1240x1240. Captured with the Phoenix ICON (100° field of view). Wide-field fundus photograph from neonatal ROP screening:
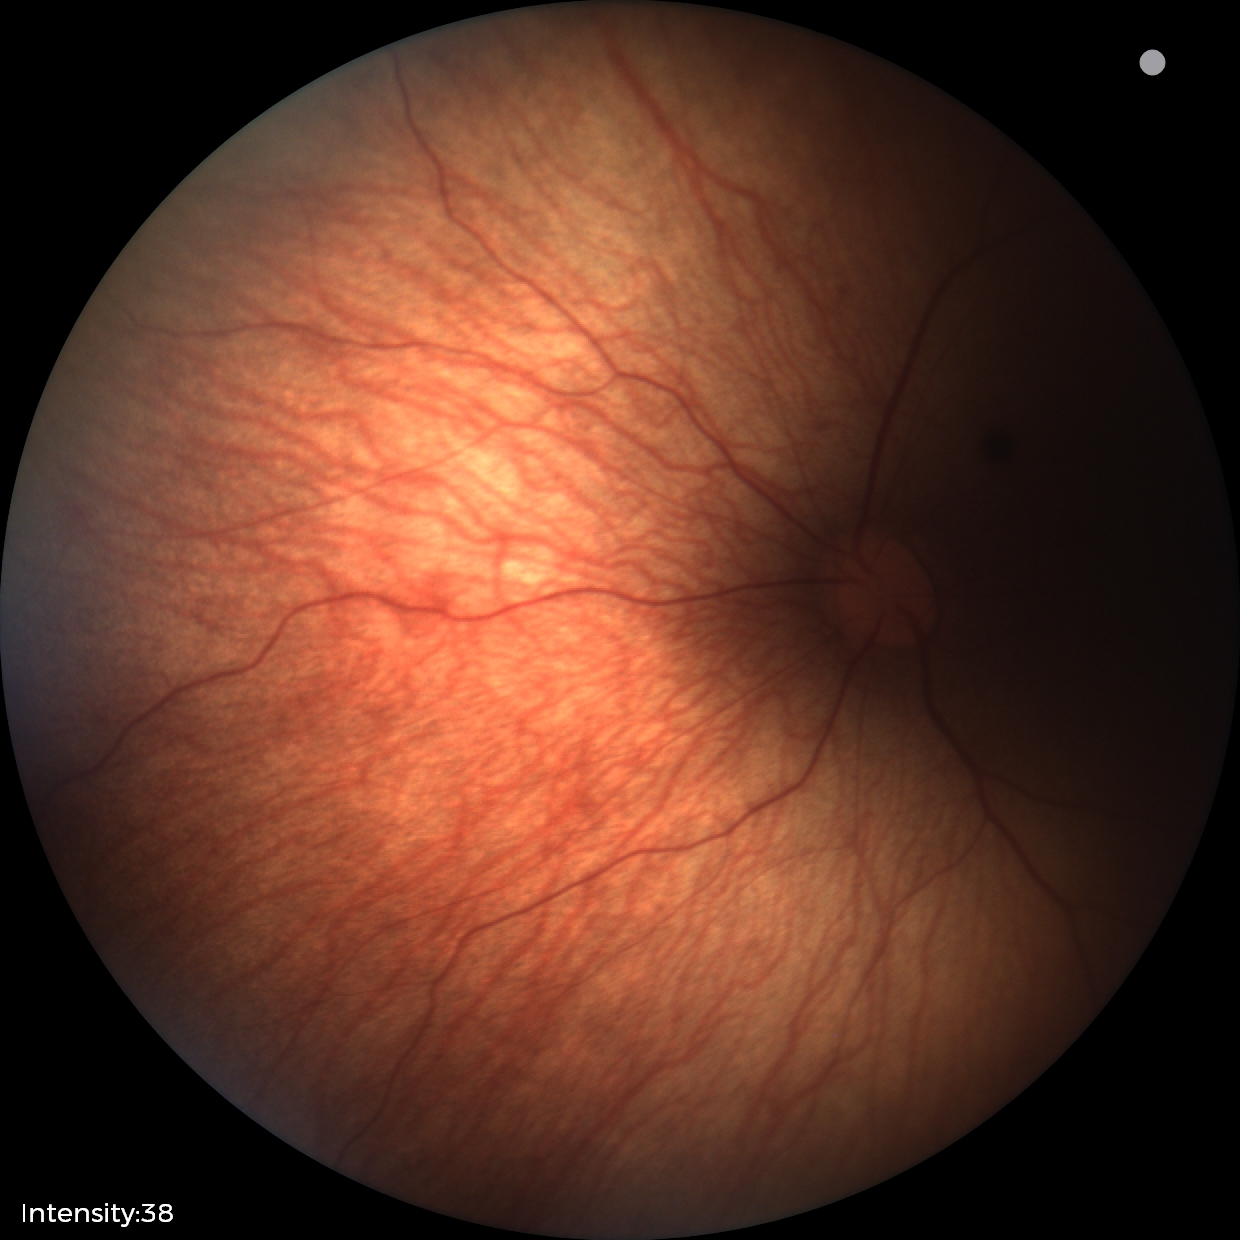 Impression: retinal hemorrhages.